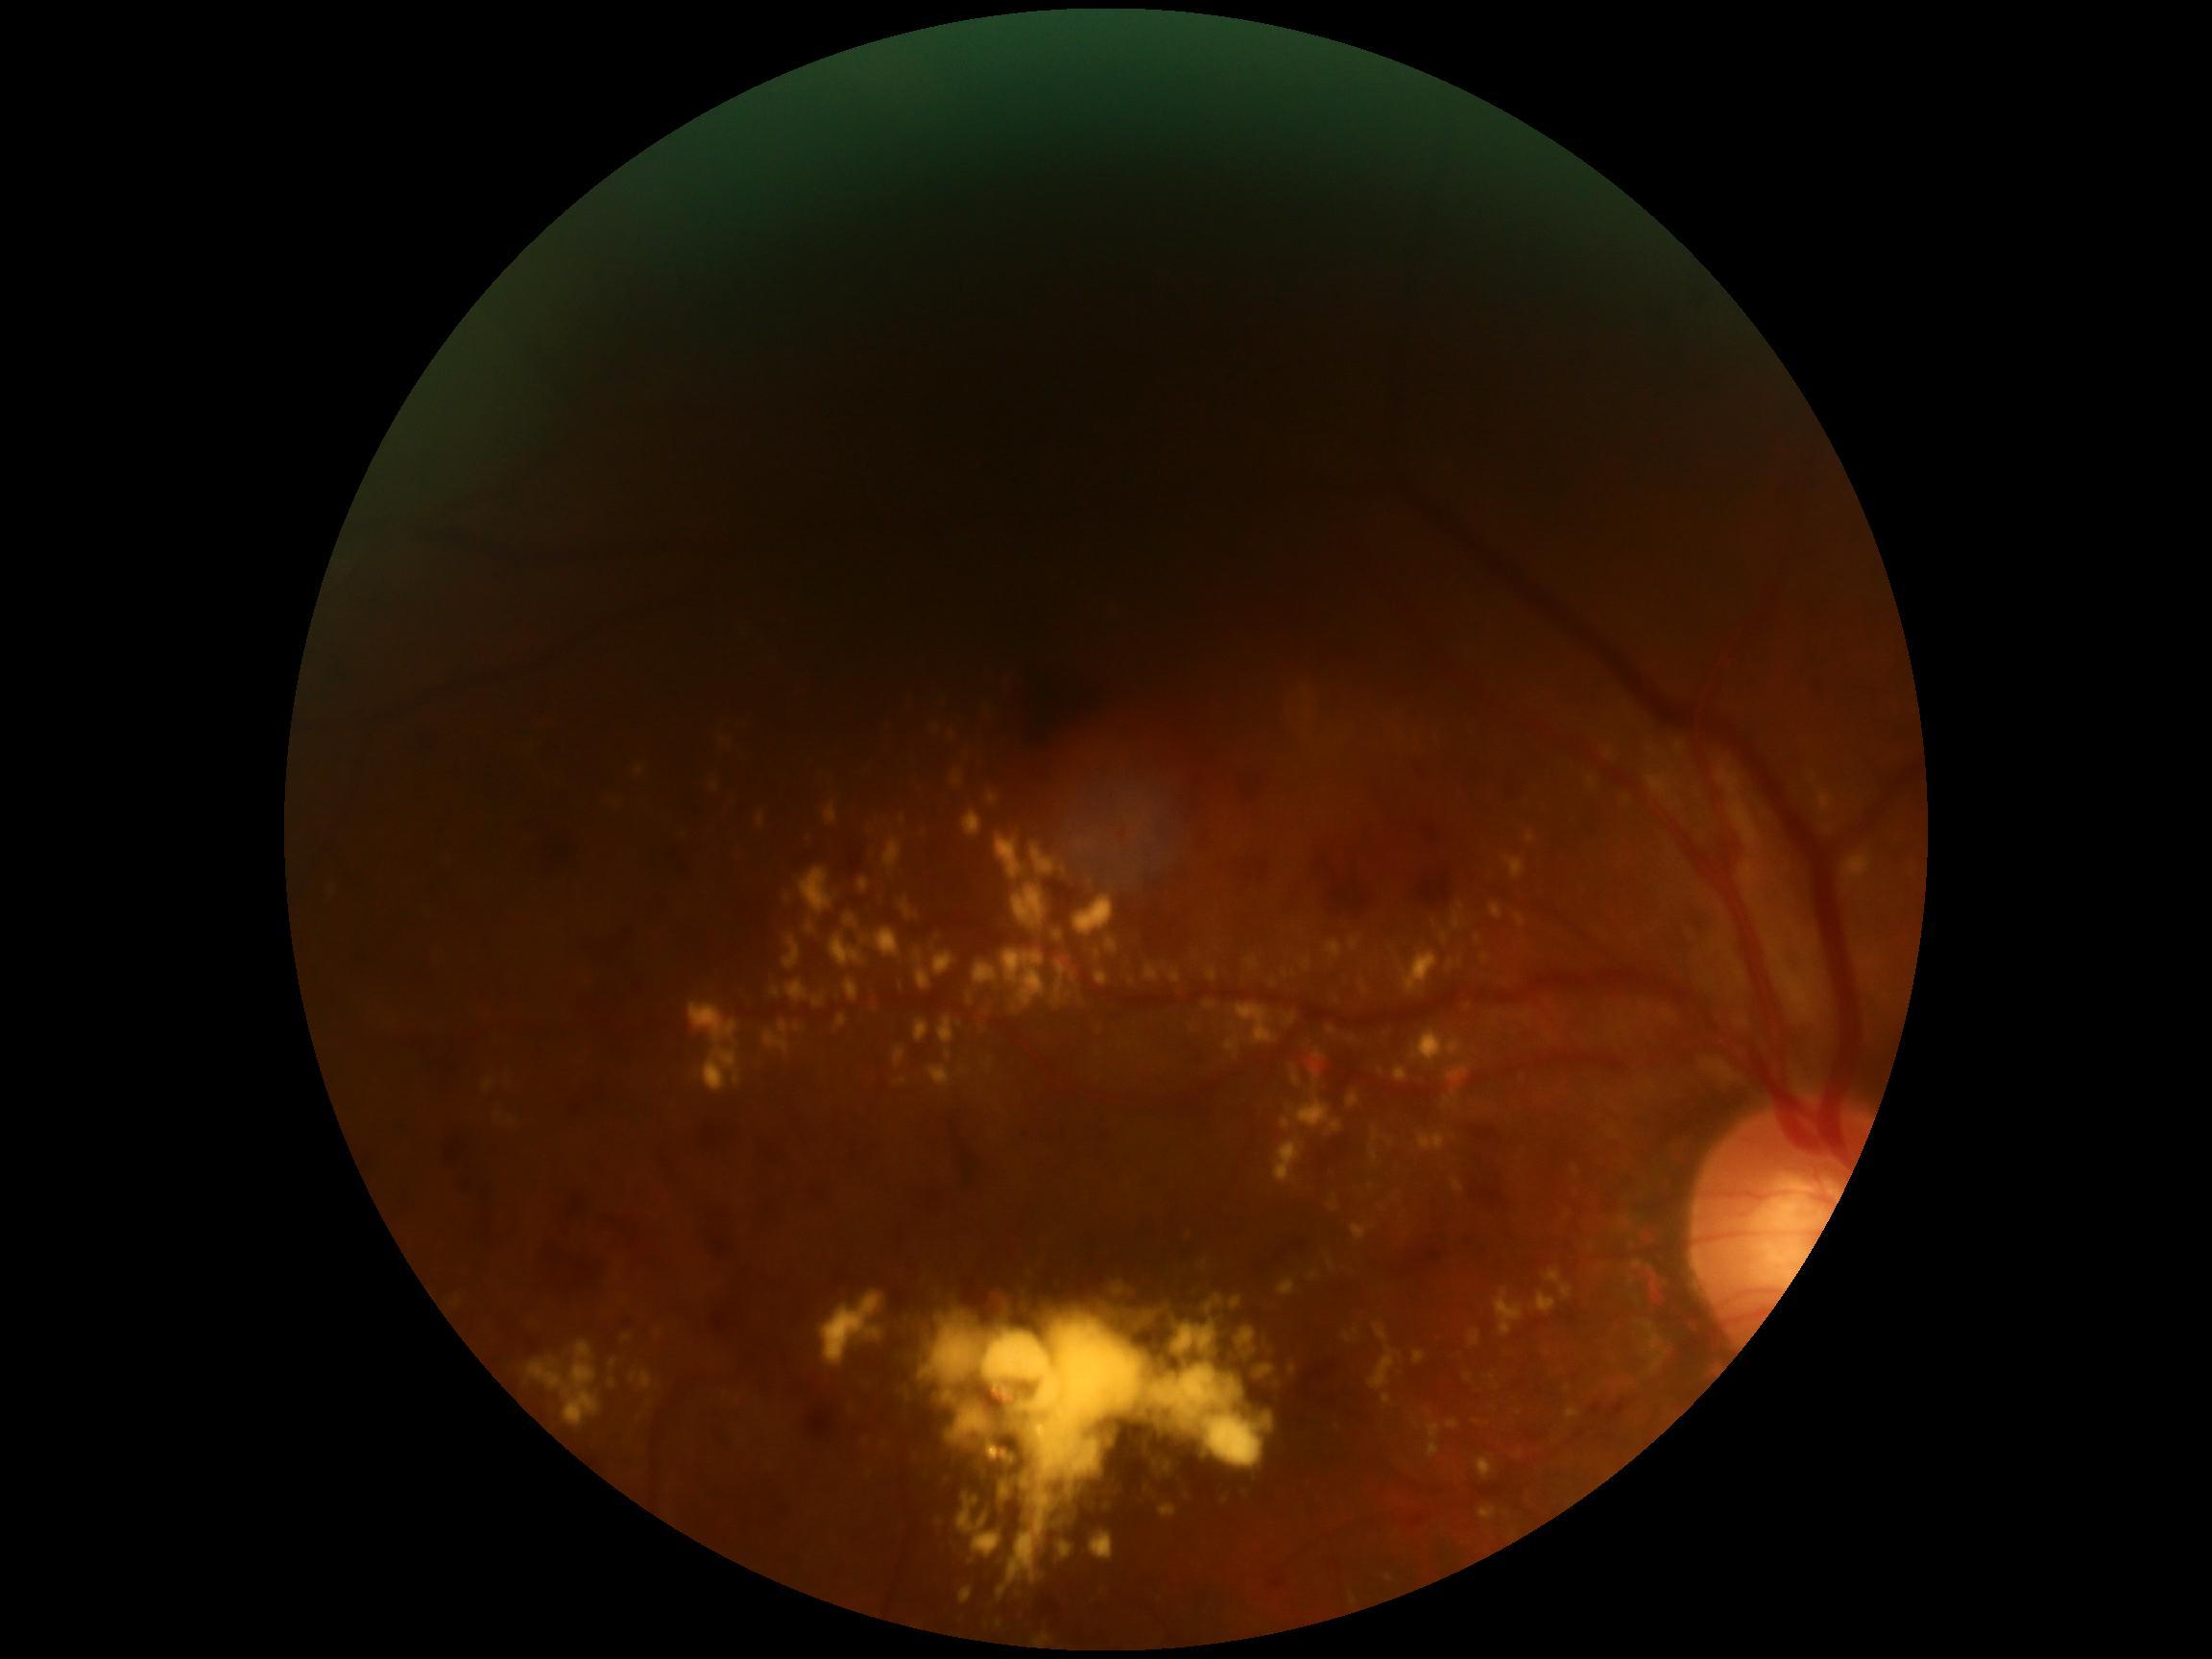
DR class: non-proliferative diabetic retinopathy; diabetic retinopathy grade: 2 (moderate NPDR).